FOV 35° before cropping, optic disc photograph
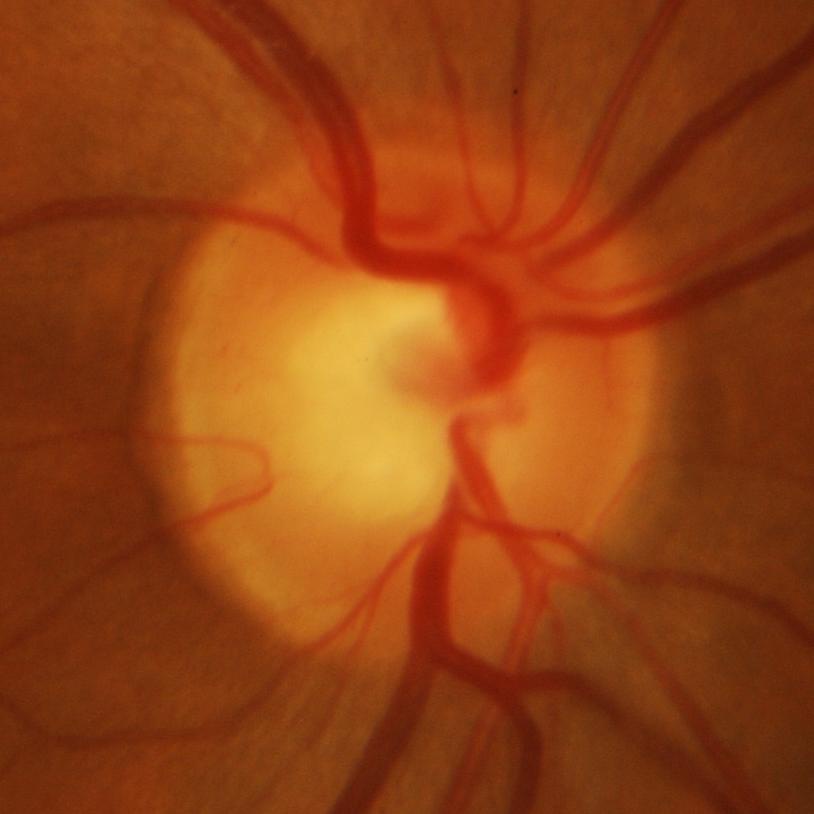

Q: Glaucoma assessment?
A: Glaucomatous damage to the optic nerve.